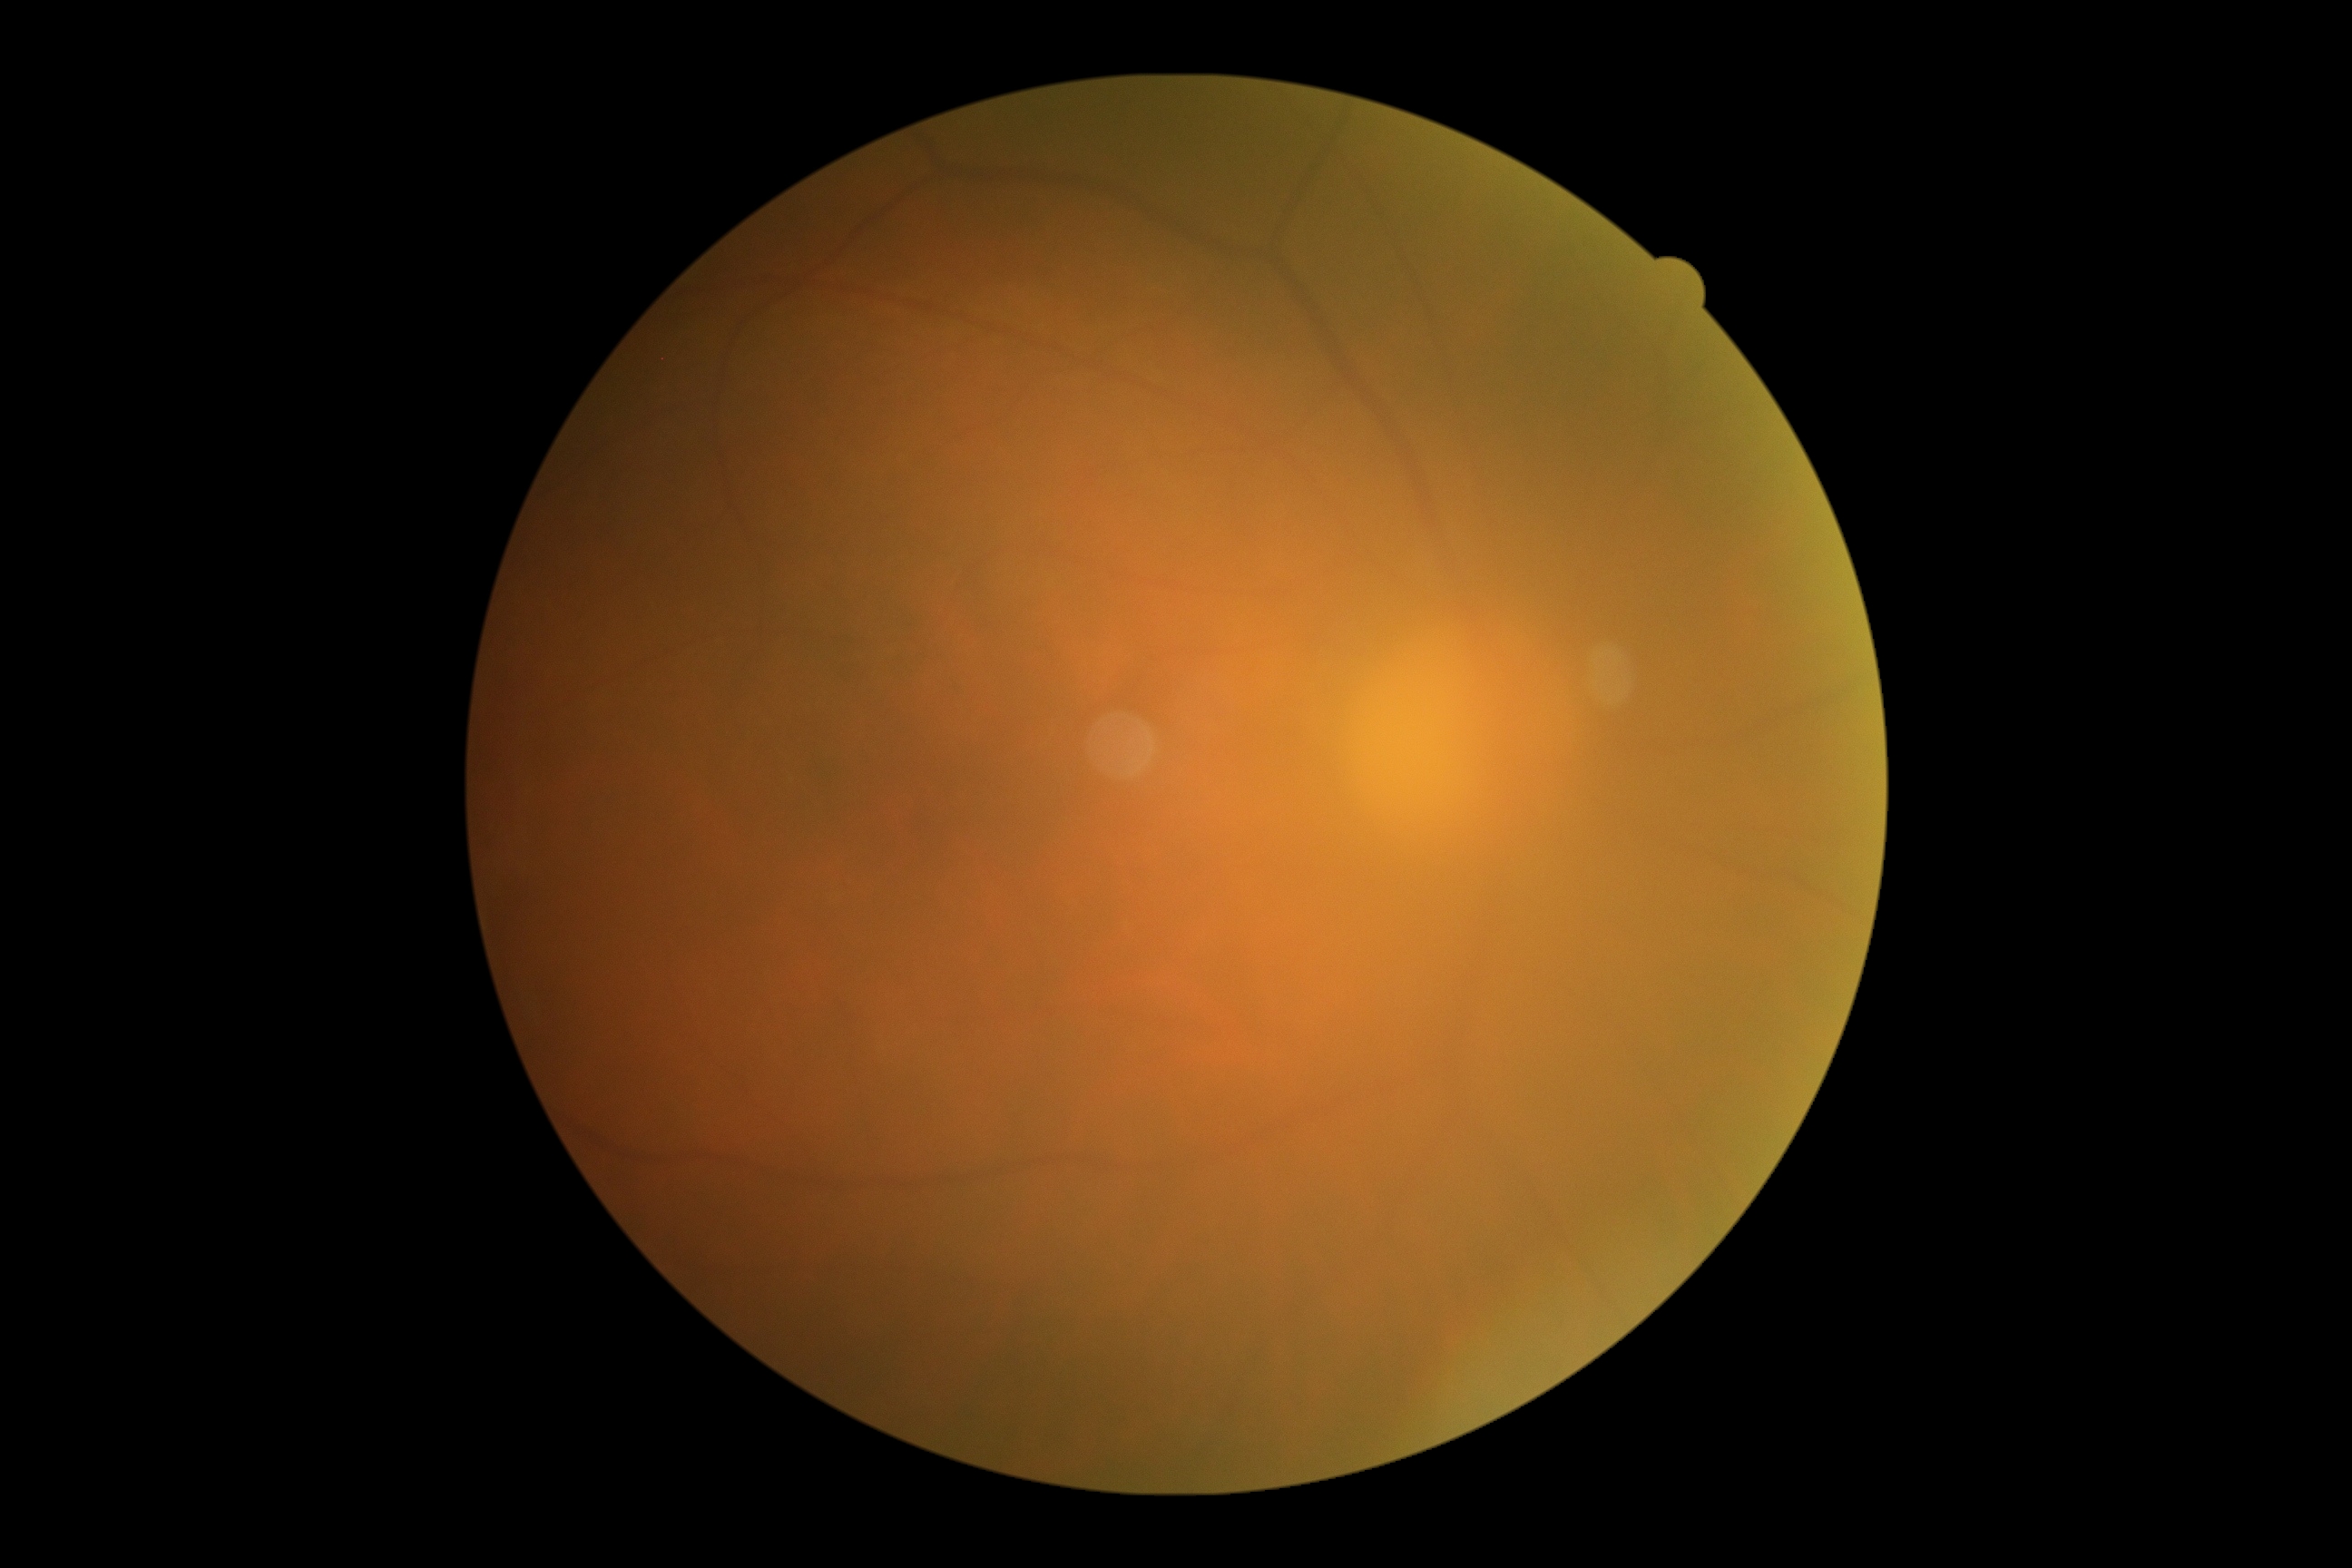

DR is grade 0 (no apparent retinopathy).